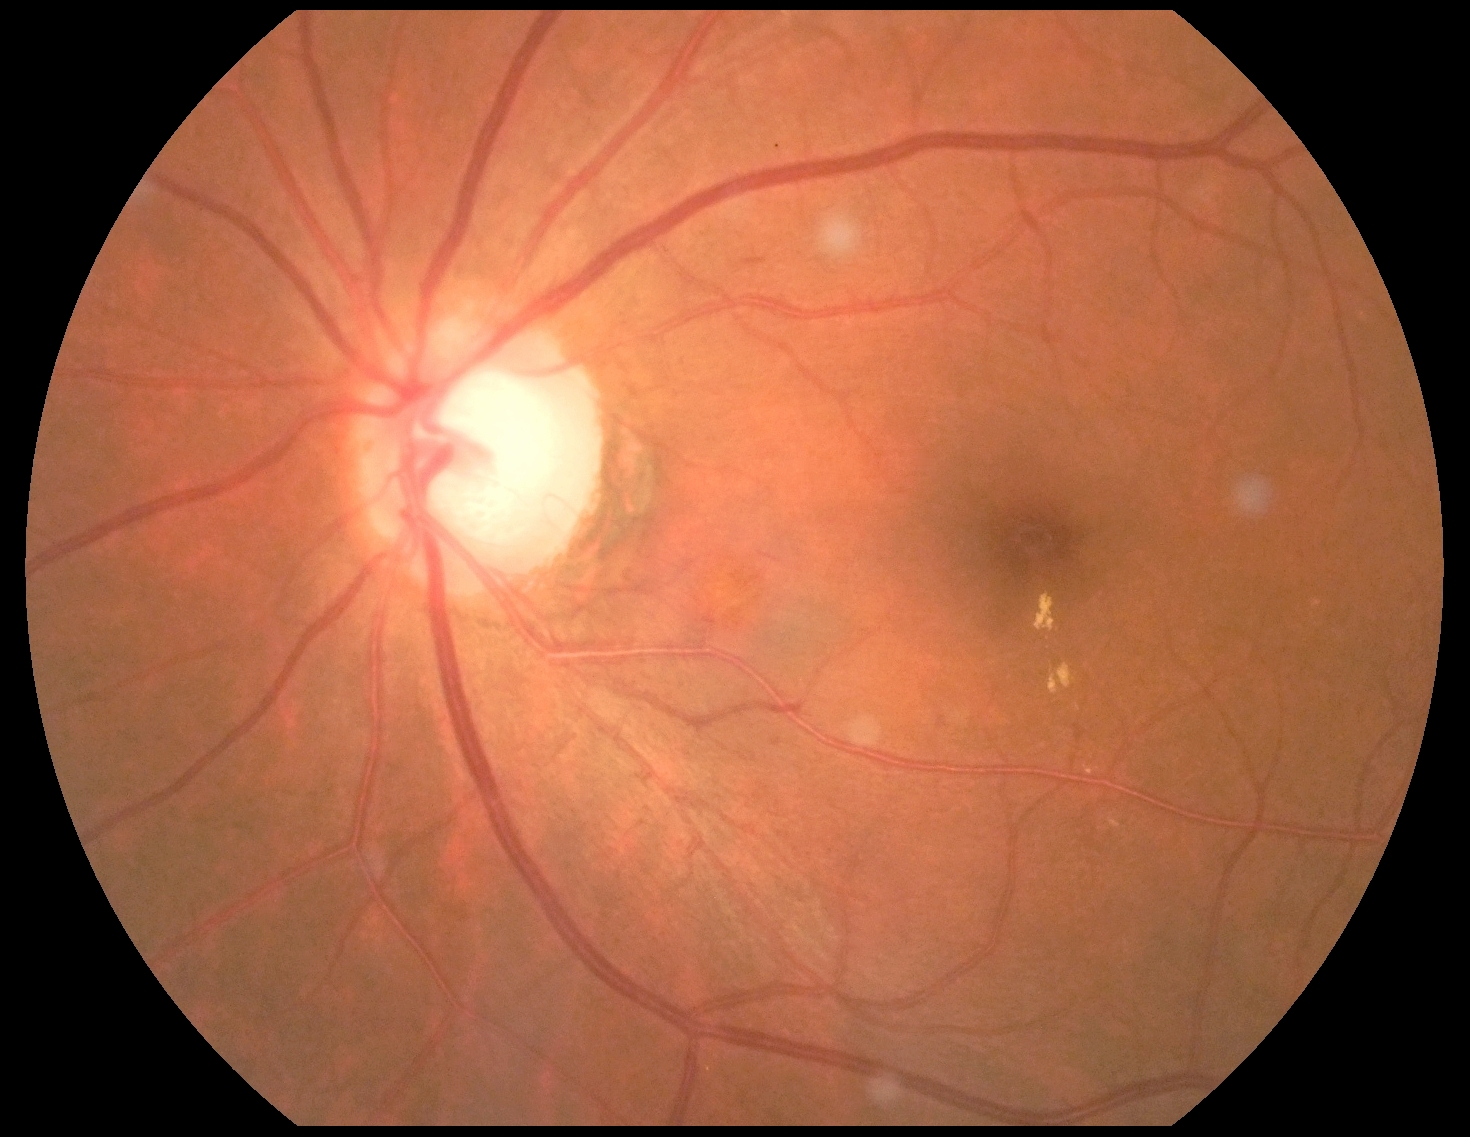 Diabetic retinopathy (DR) is moderate non-proliferative diabetic retinopathy (grade 2) — more than just microaneurysms but less than severe NPDR.